45° FOV — 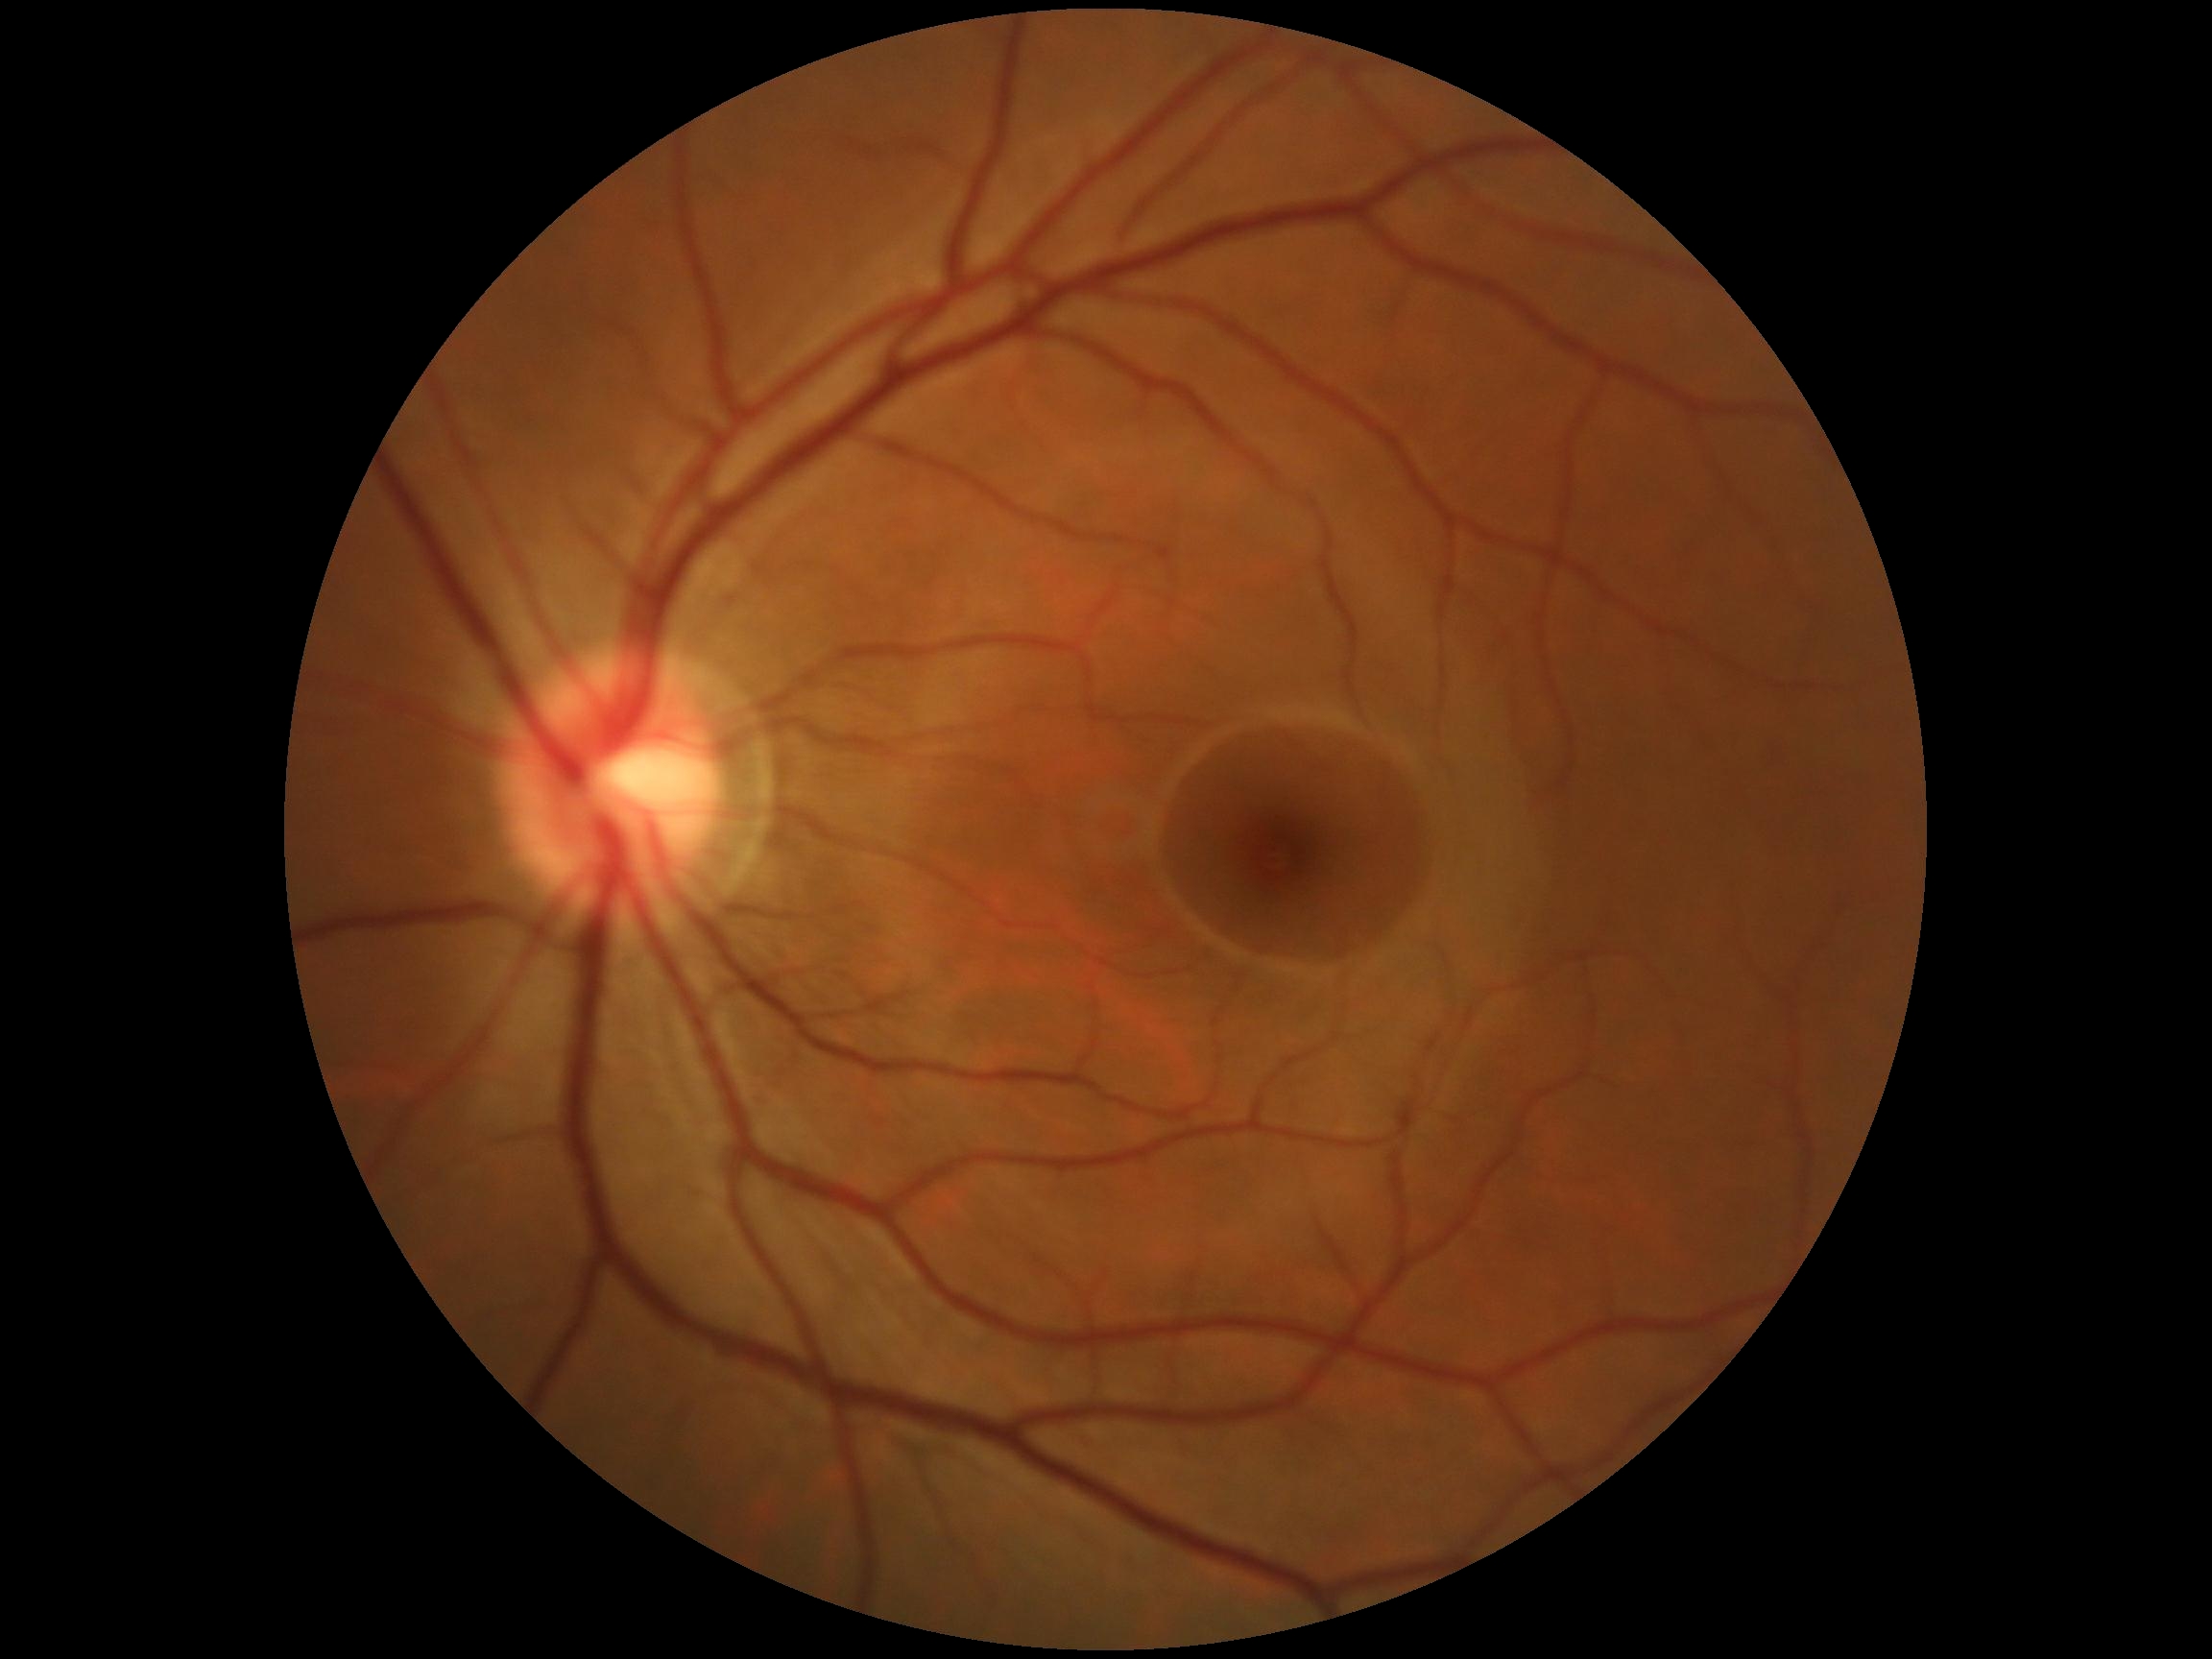 DR impression: no DR findings, diabetic retinopathy (DR): grade 0.